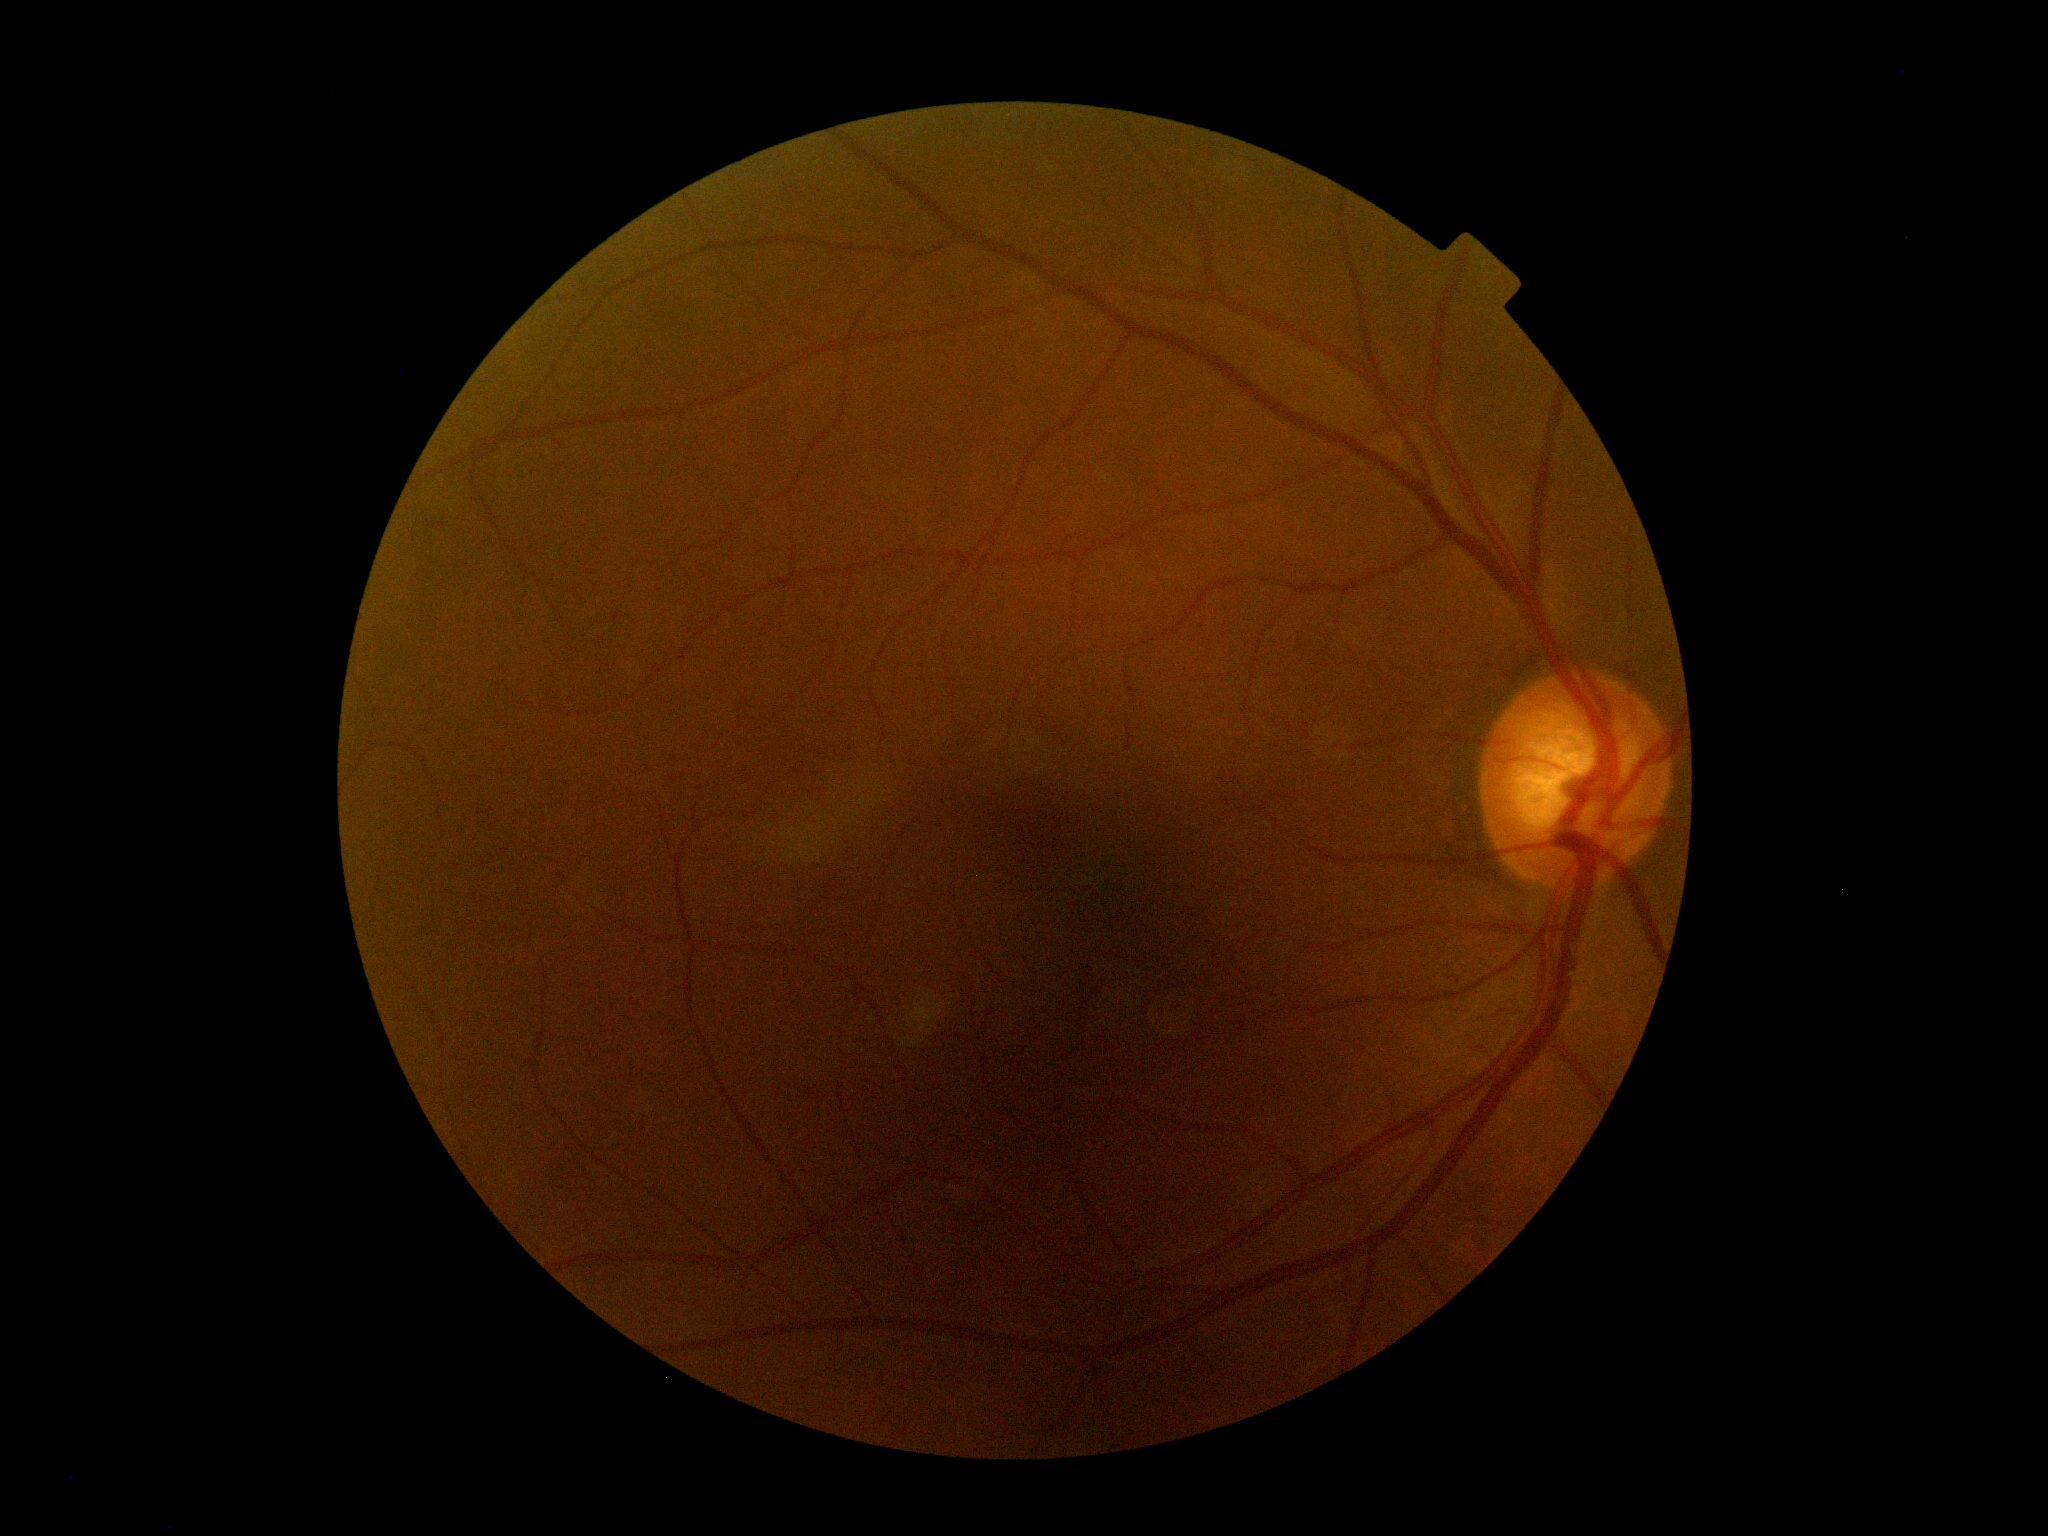 Diabetic retinopathy (DR) is 0.